1536 x 1152 pixels; 45° field of view — 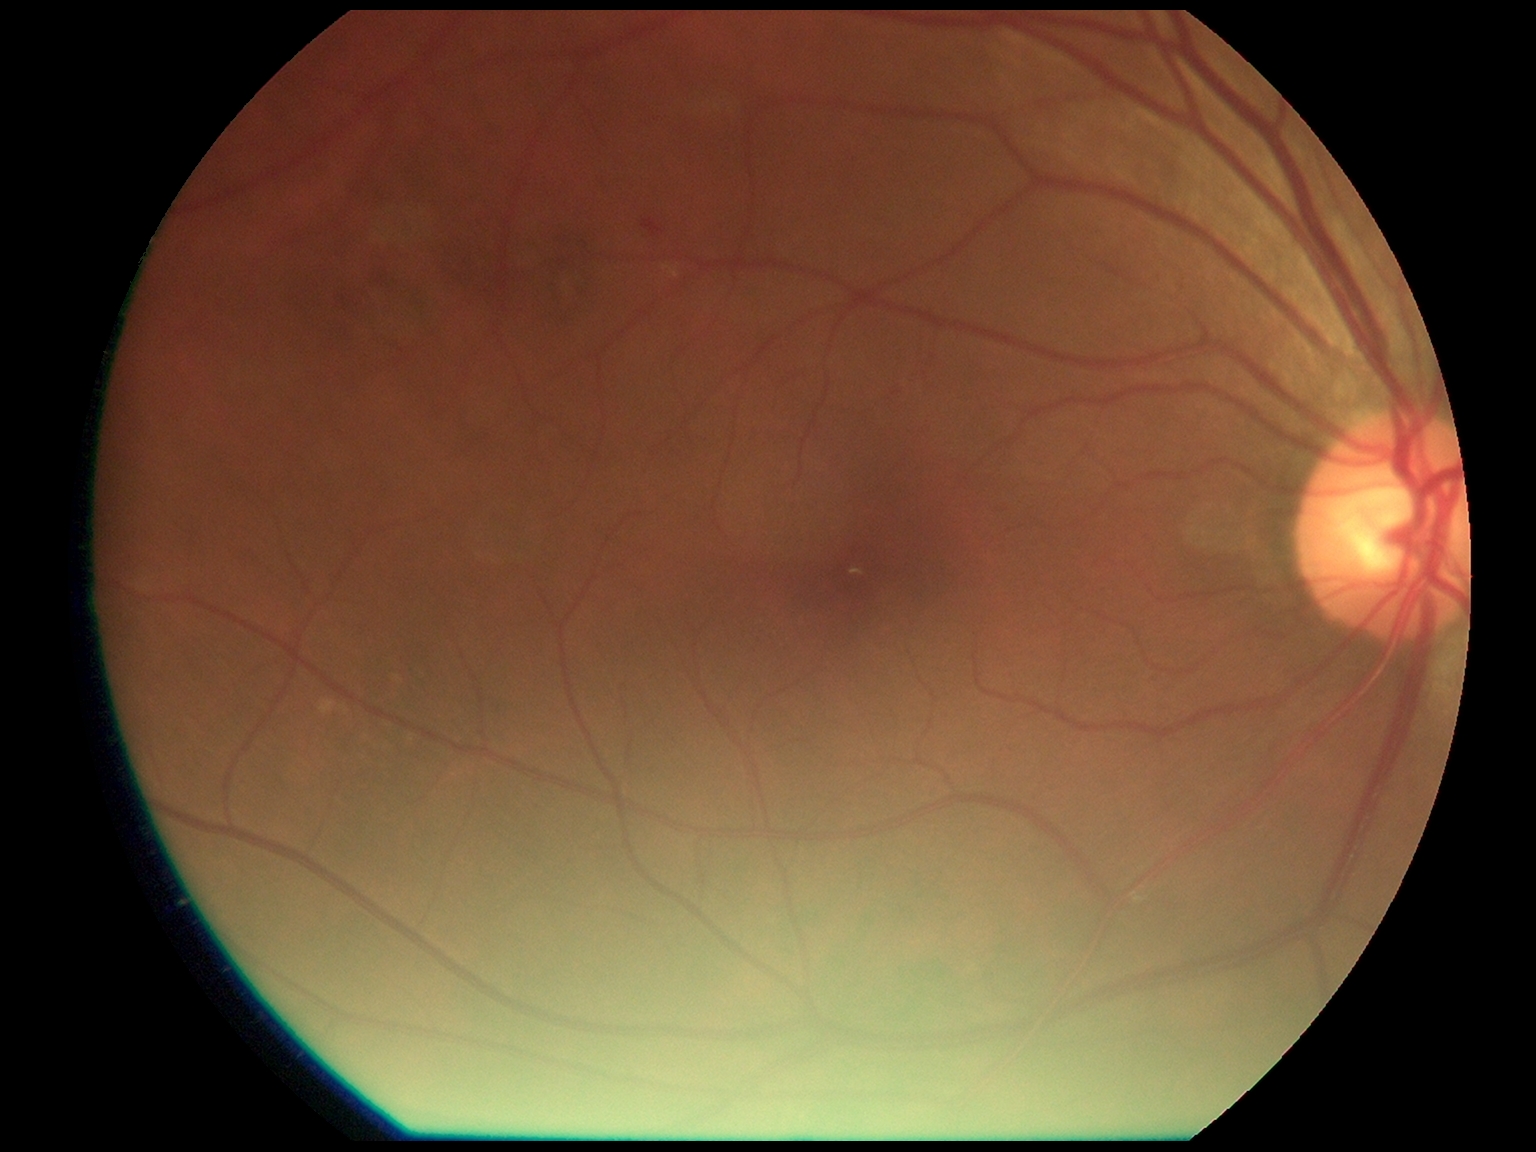

DR severity is grade 1 (mild NPDR).